CFP. 45° FOV.
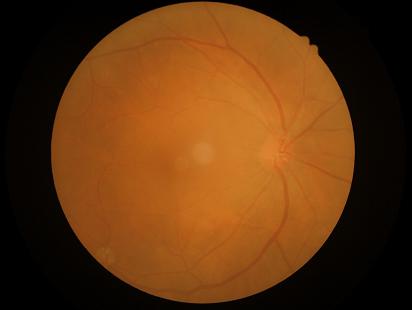
No over- or under-exposure. Overall quality is poor; the image is difficult to grade. Contrast is good. The image is blurry.